Centered on the optic disc. Non-mydriatic acquisition.
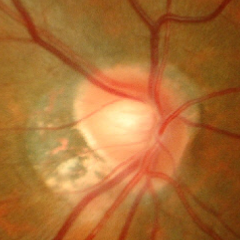
Demonstrates early glaucomatous changes.